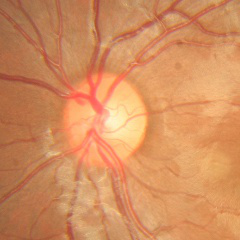

Glaucoma status: no signs of glaucoma.